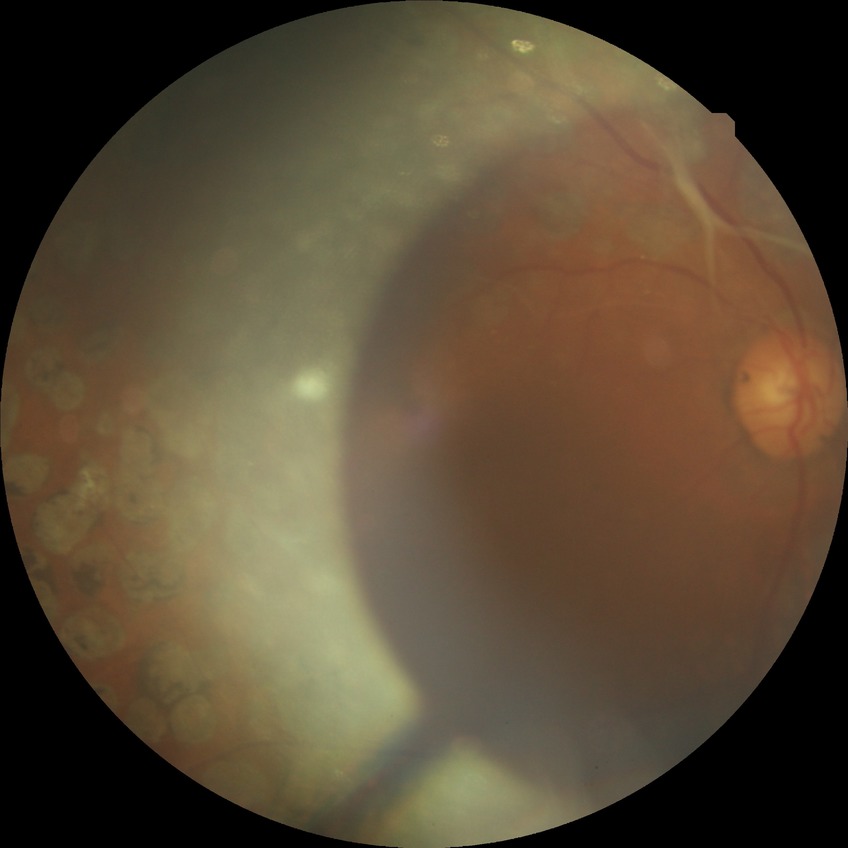 Retinopathy stage: proliferative diabetic retinopathy.